Camera: Clarity RetCam 3 (130° FOV); infant wide-field fundus photograph
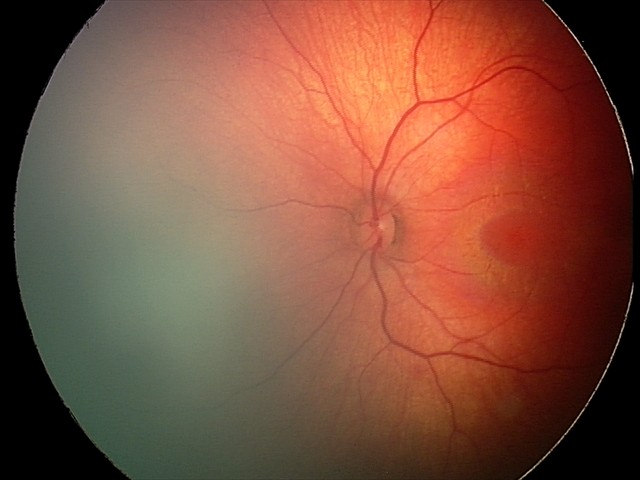 Examination diagnosed as retinal hemorrhages.